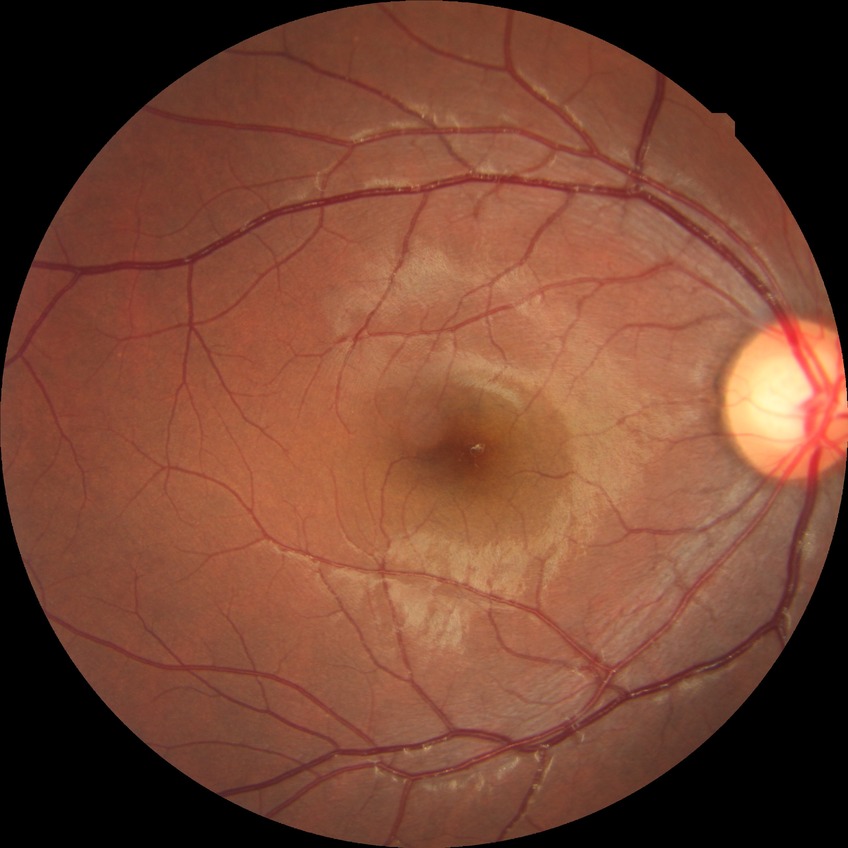

Modified Davis grading: no diabetic retinopathy.